848x848px · nonmydriatic · graded on the modified Davis scale
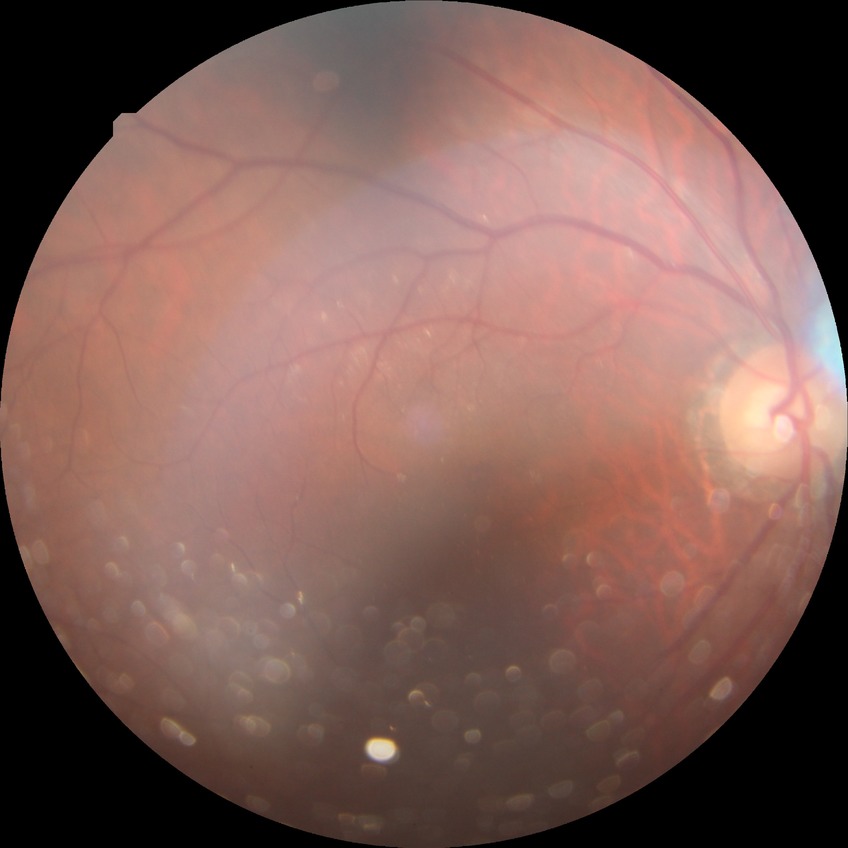

Retinopathy grade is no diabetic retinopathy.